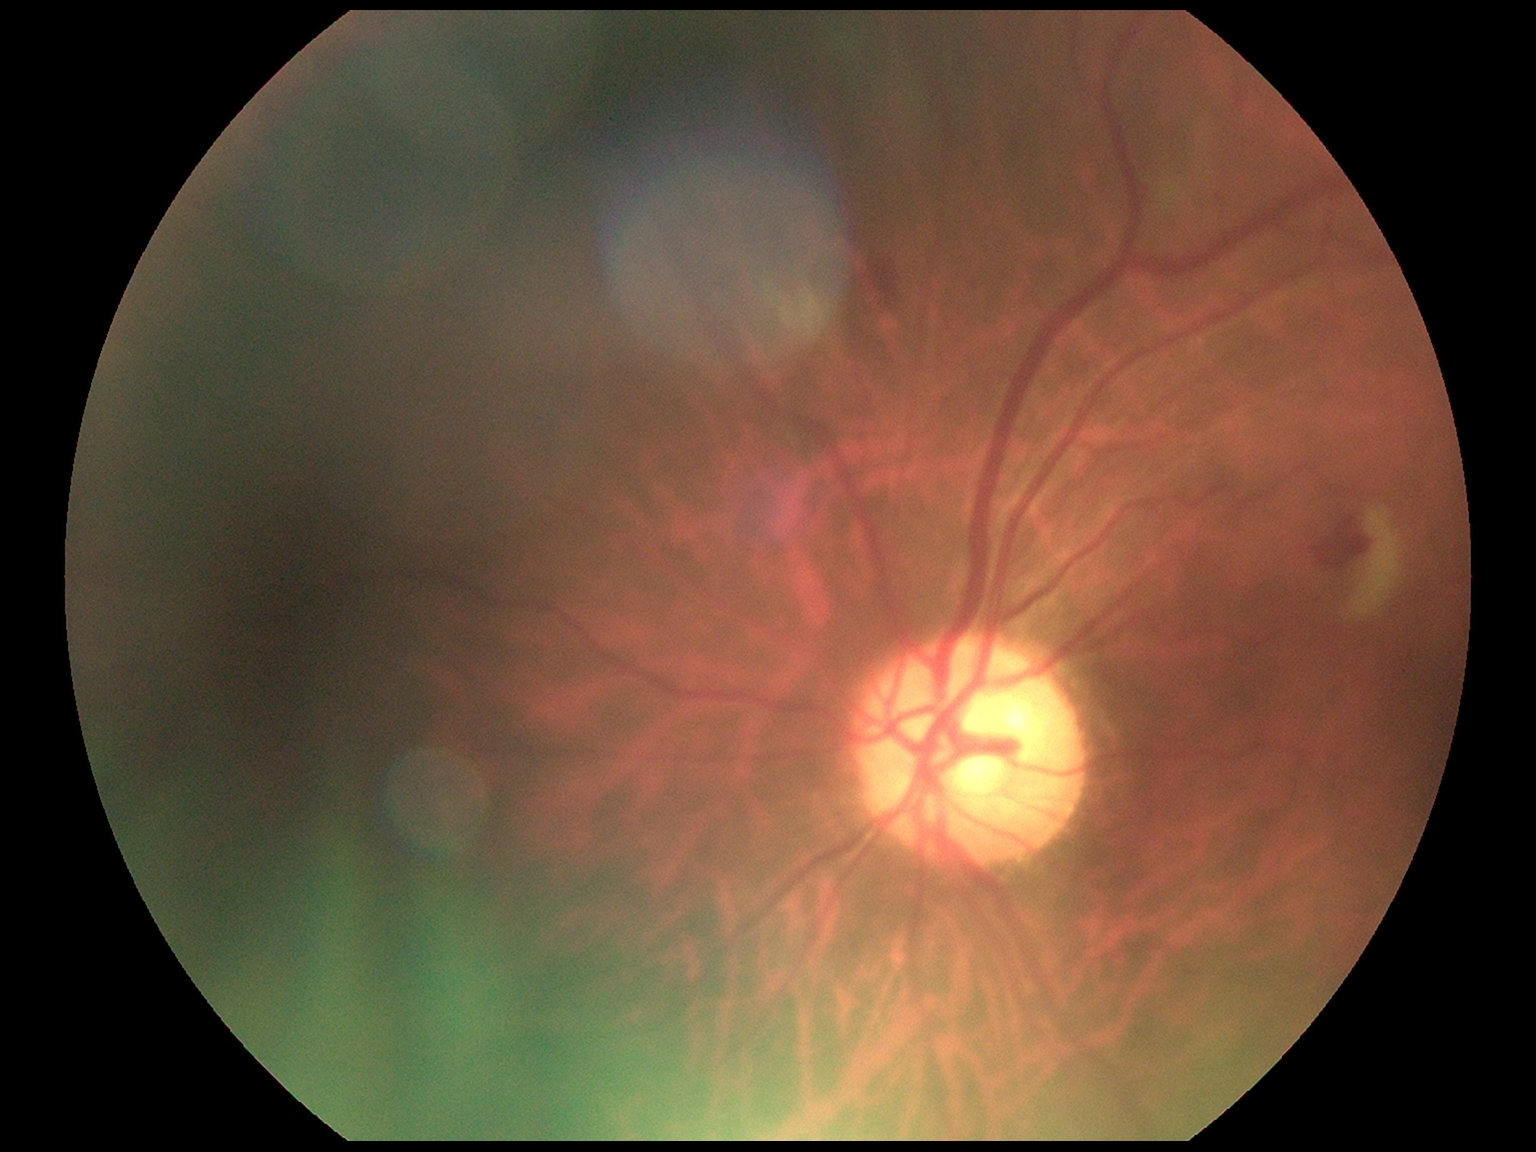

Retinopathy is grade 2.